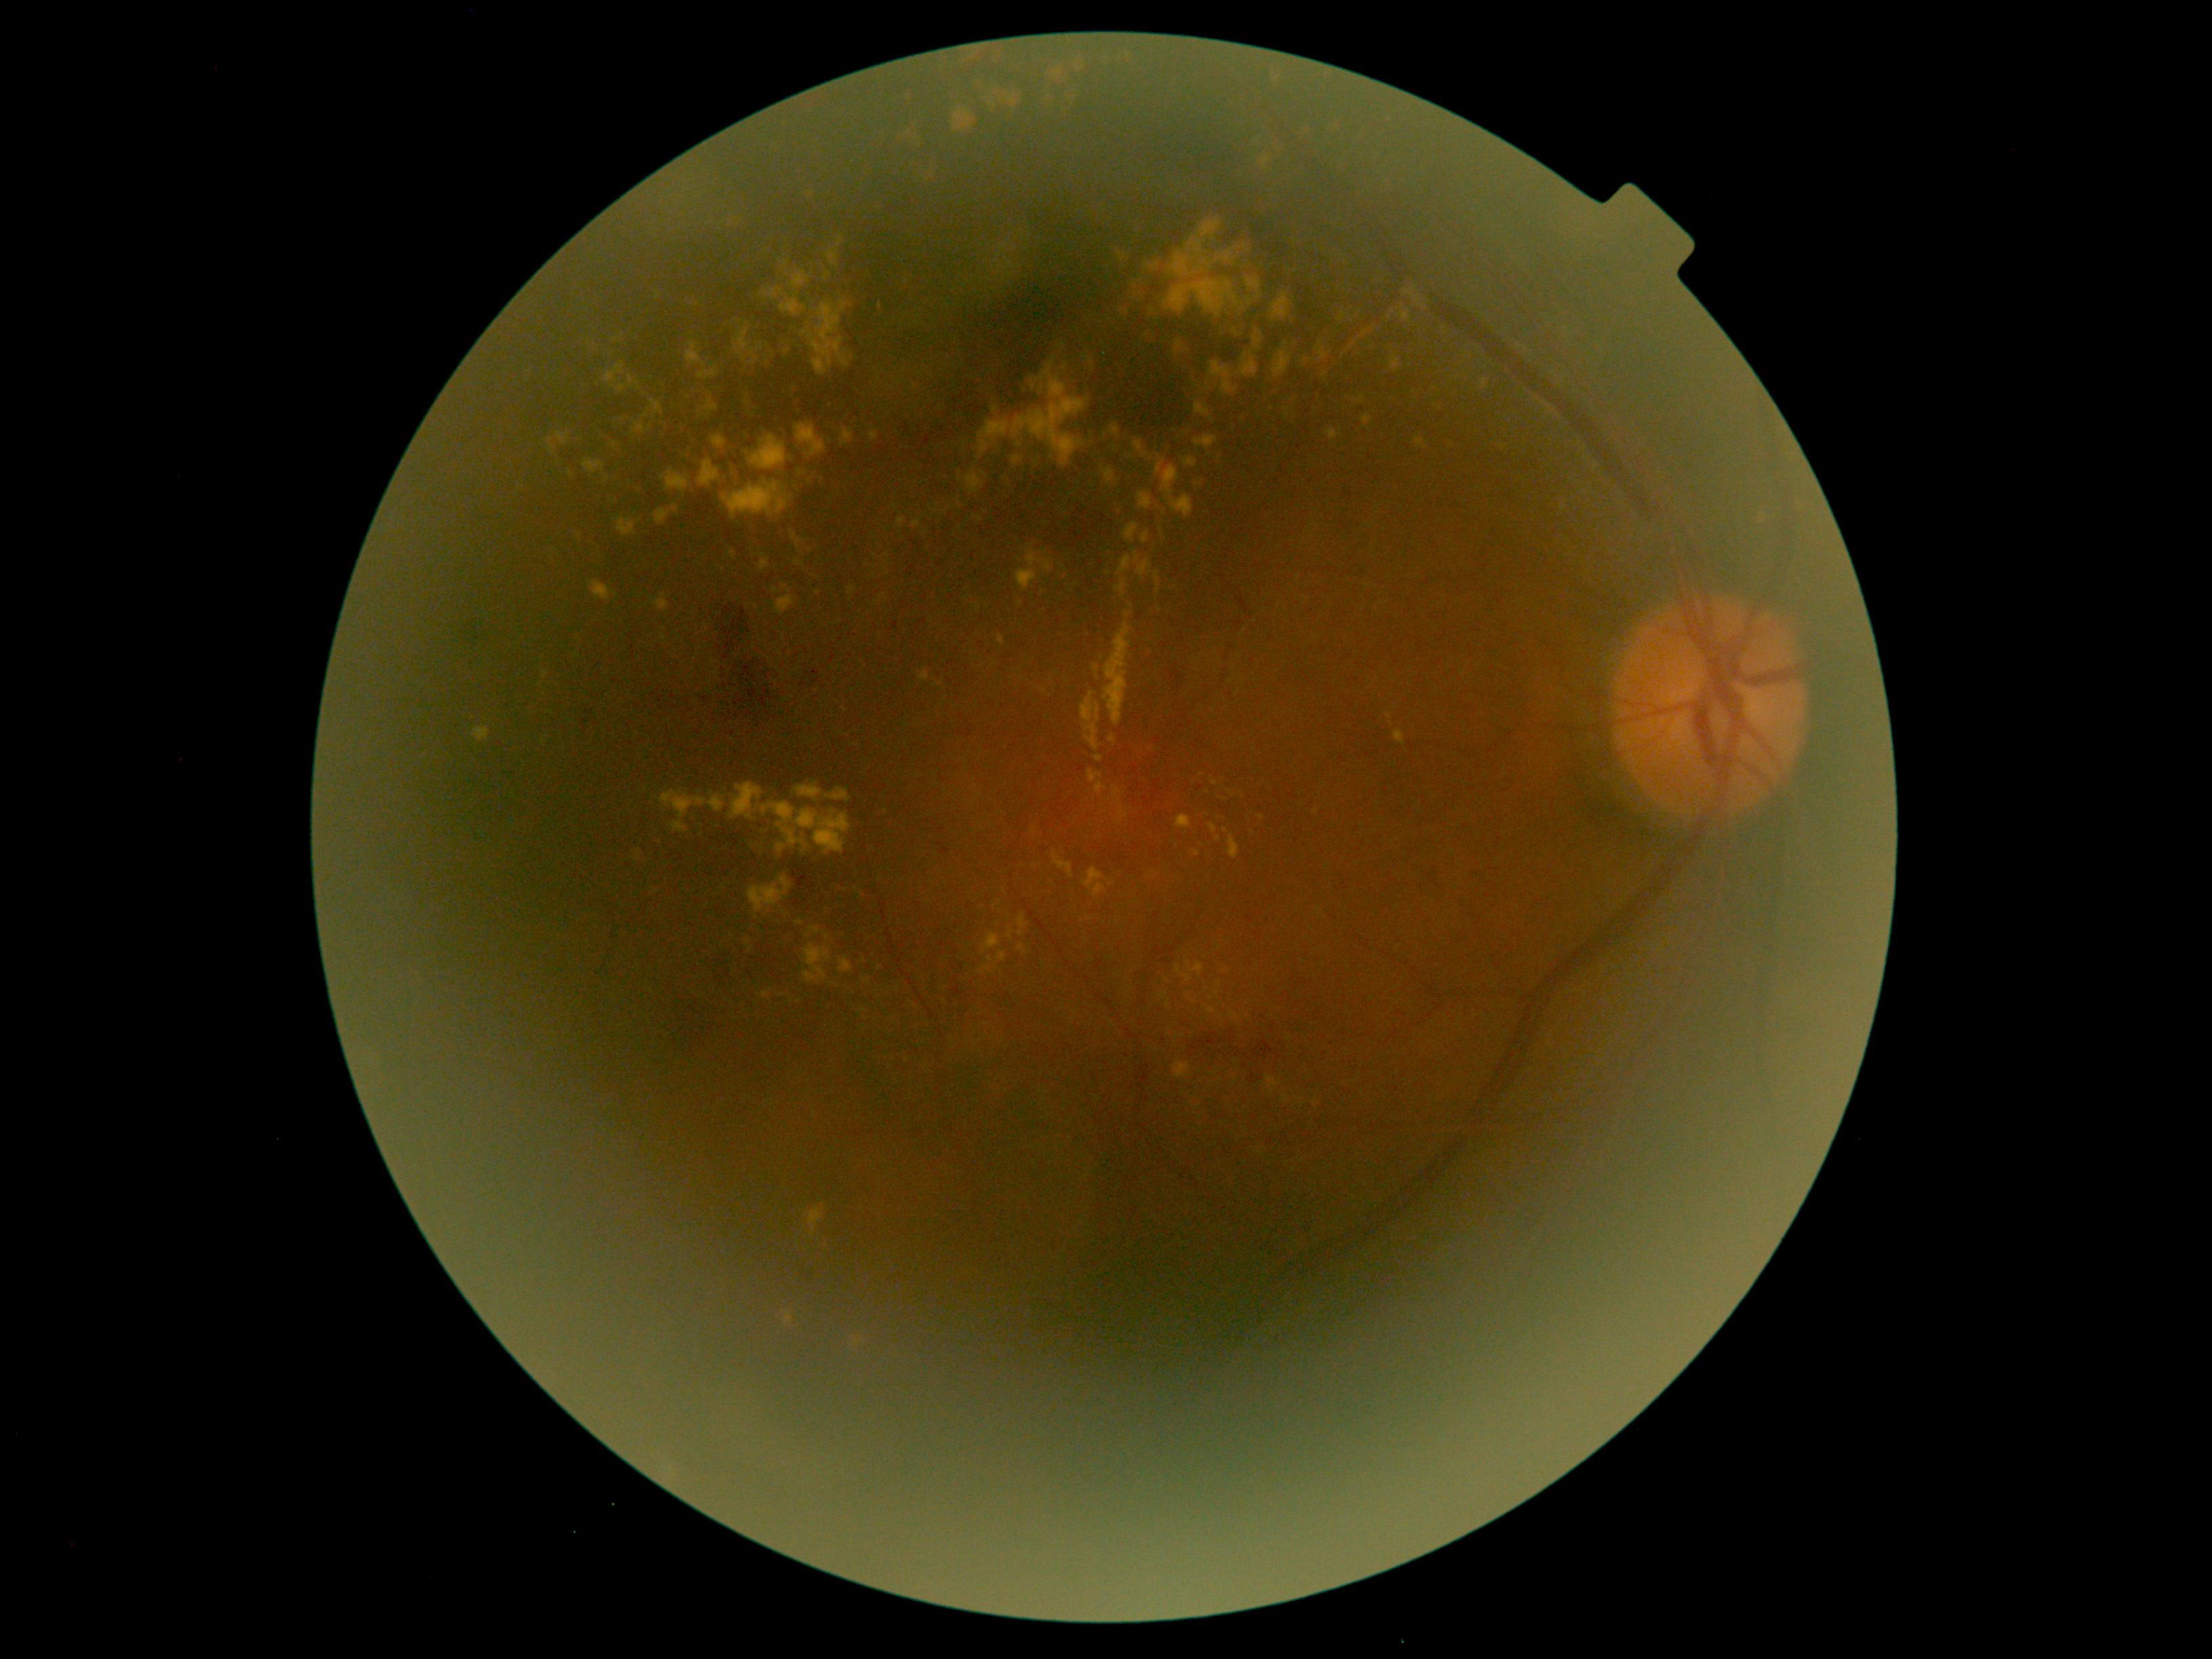

Retinopathy grade: 2 (moderate NPDR) — more than just microaneurysms but less than severe NPDR. Hard exudates include (895,517,906,529); (1193,402,1210,417); (757,991,769,998); (659,790,726,834); (795,424,827,457); (604,361,626,386); (1176,341,1188,357); (998,952,1008,963); (1173,1062,1191,1080); (1282,1096,1290,1104); (1240,354,1257,377). Hard exudates (small, approximate centers) near 960:478; 1196:854; 1352:346; 571:474; 1322:342; 712:660; 1504:447; 767:362; 991:959.